Acquired on the Phoenix ICON · wide-field fundus photograph of an infant: 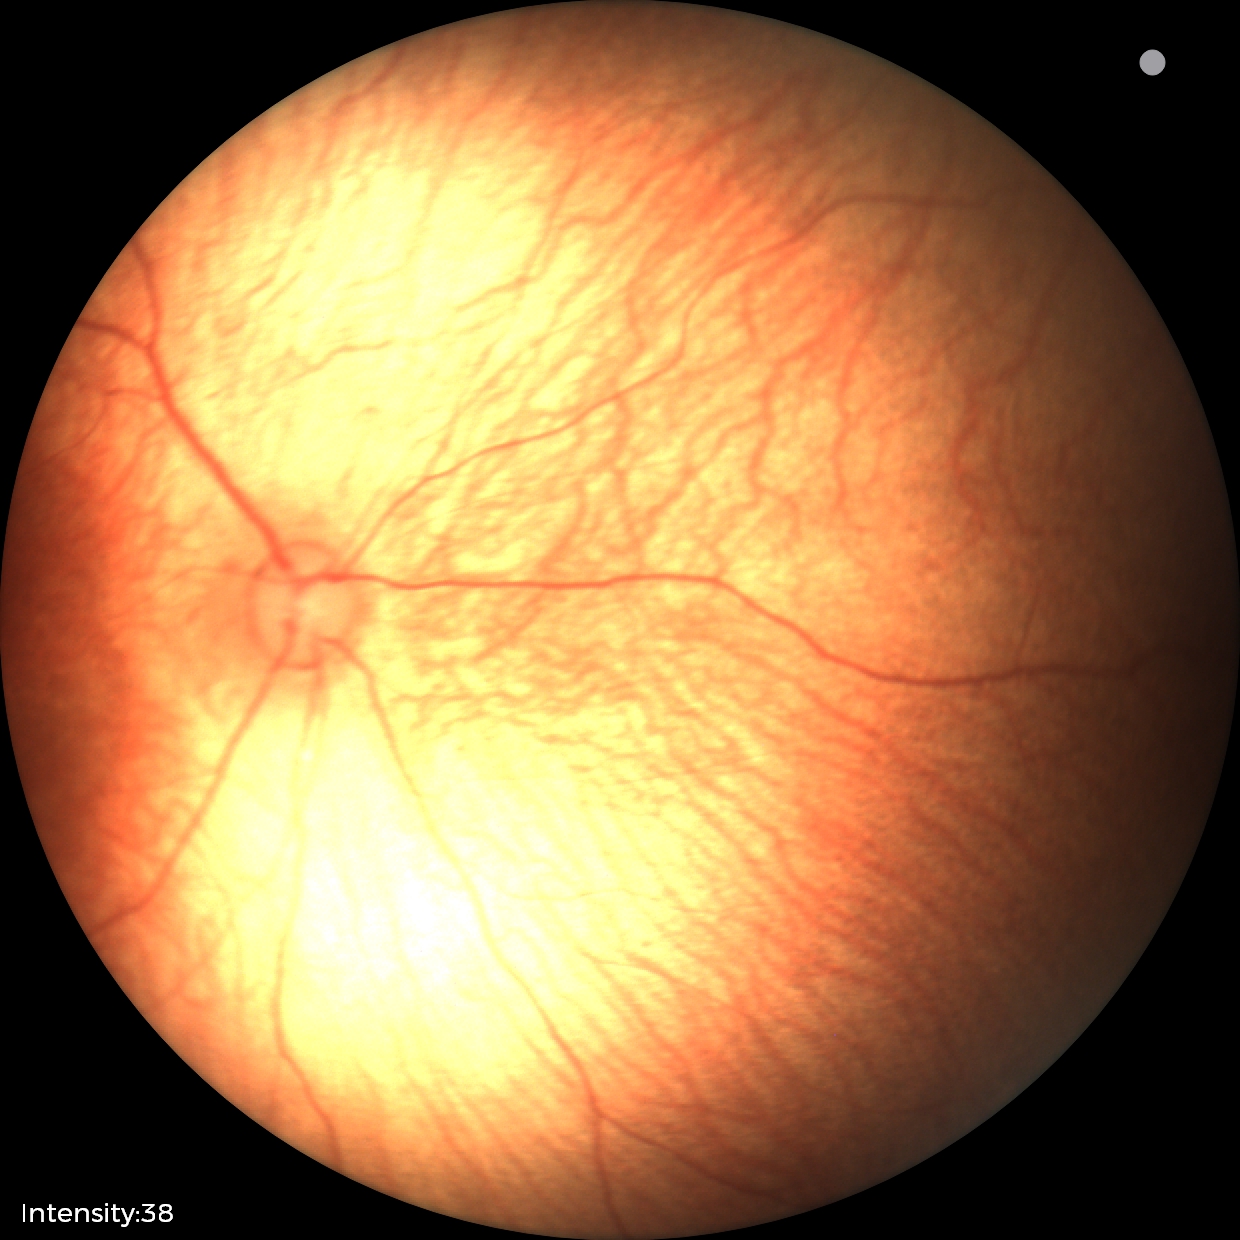 Screening examination diagnosed as physiological.